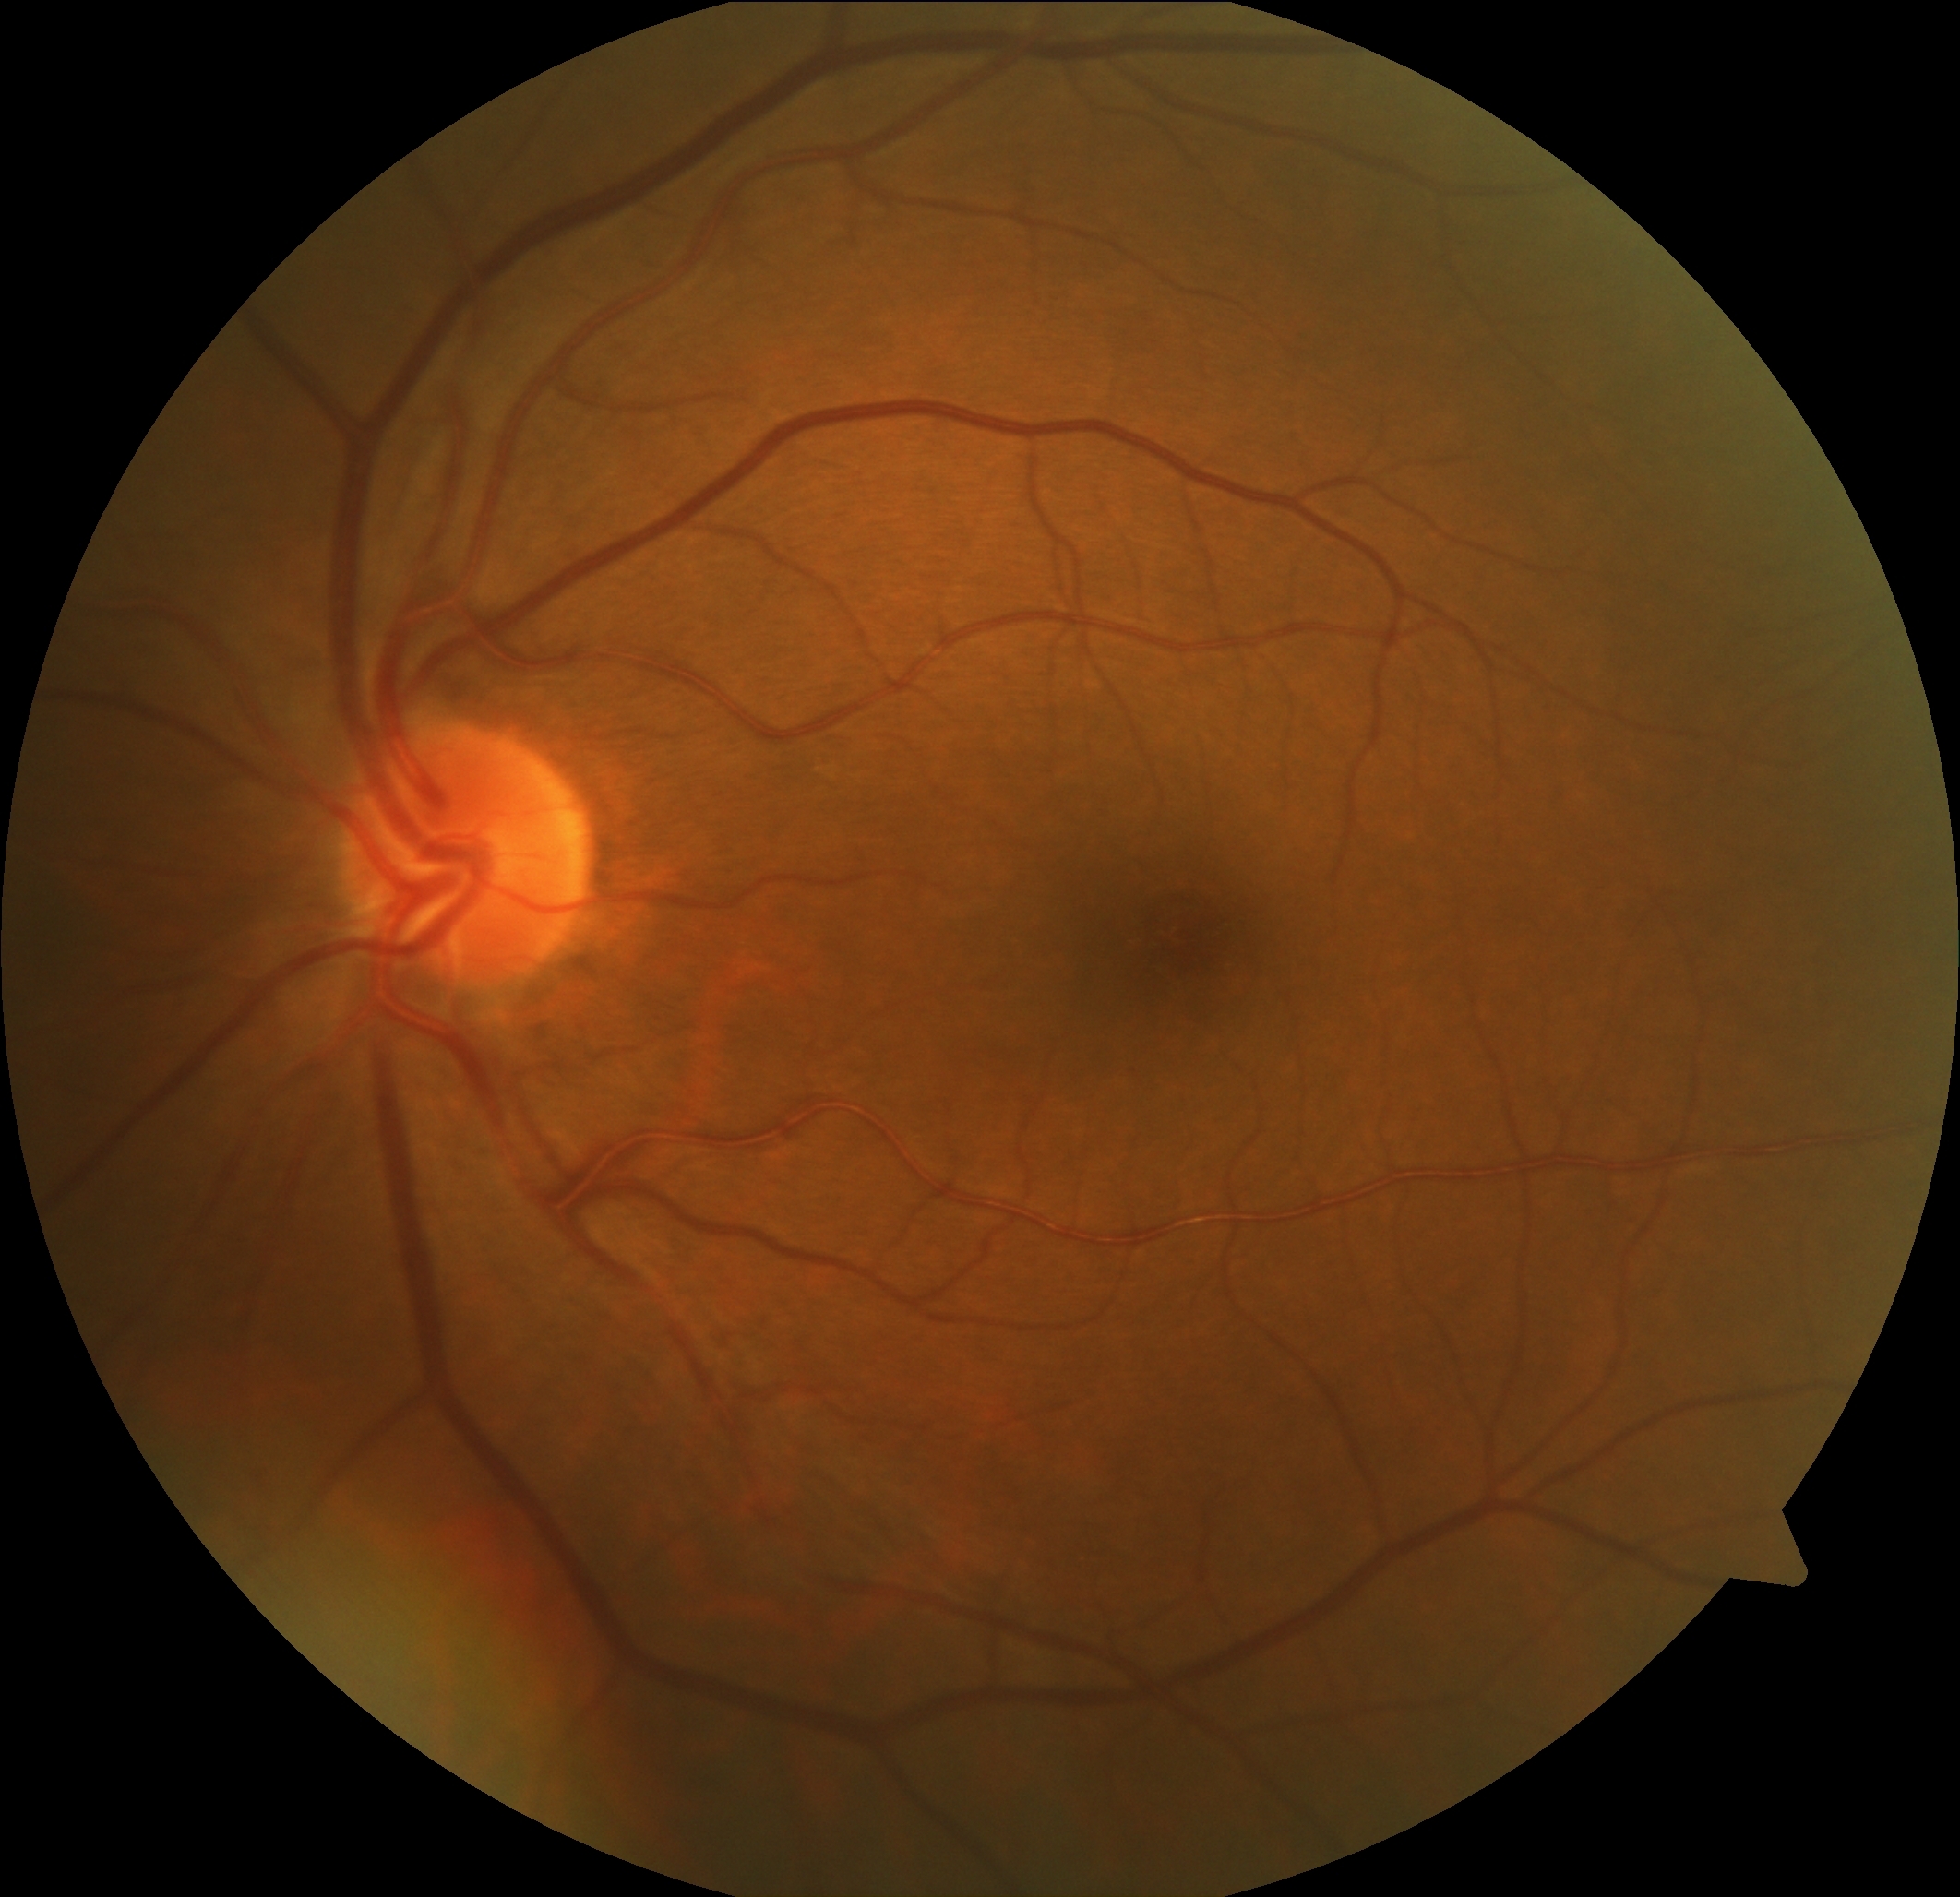

DR impression = negative for DR, diabetic retinopathy grade = no apparent retinopathy (0).